Retinal fundus photograph:
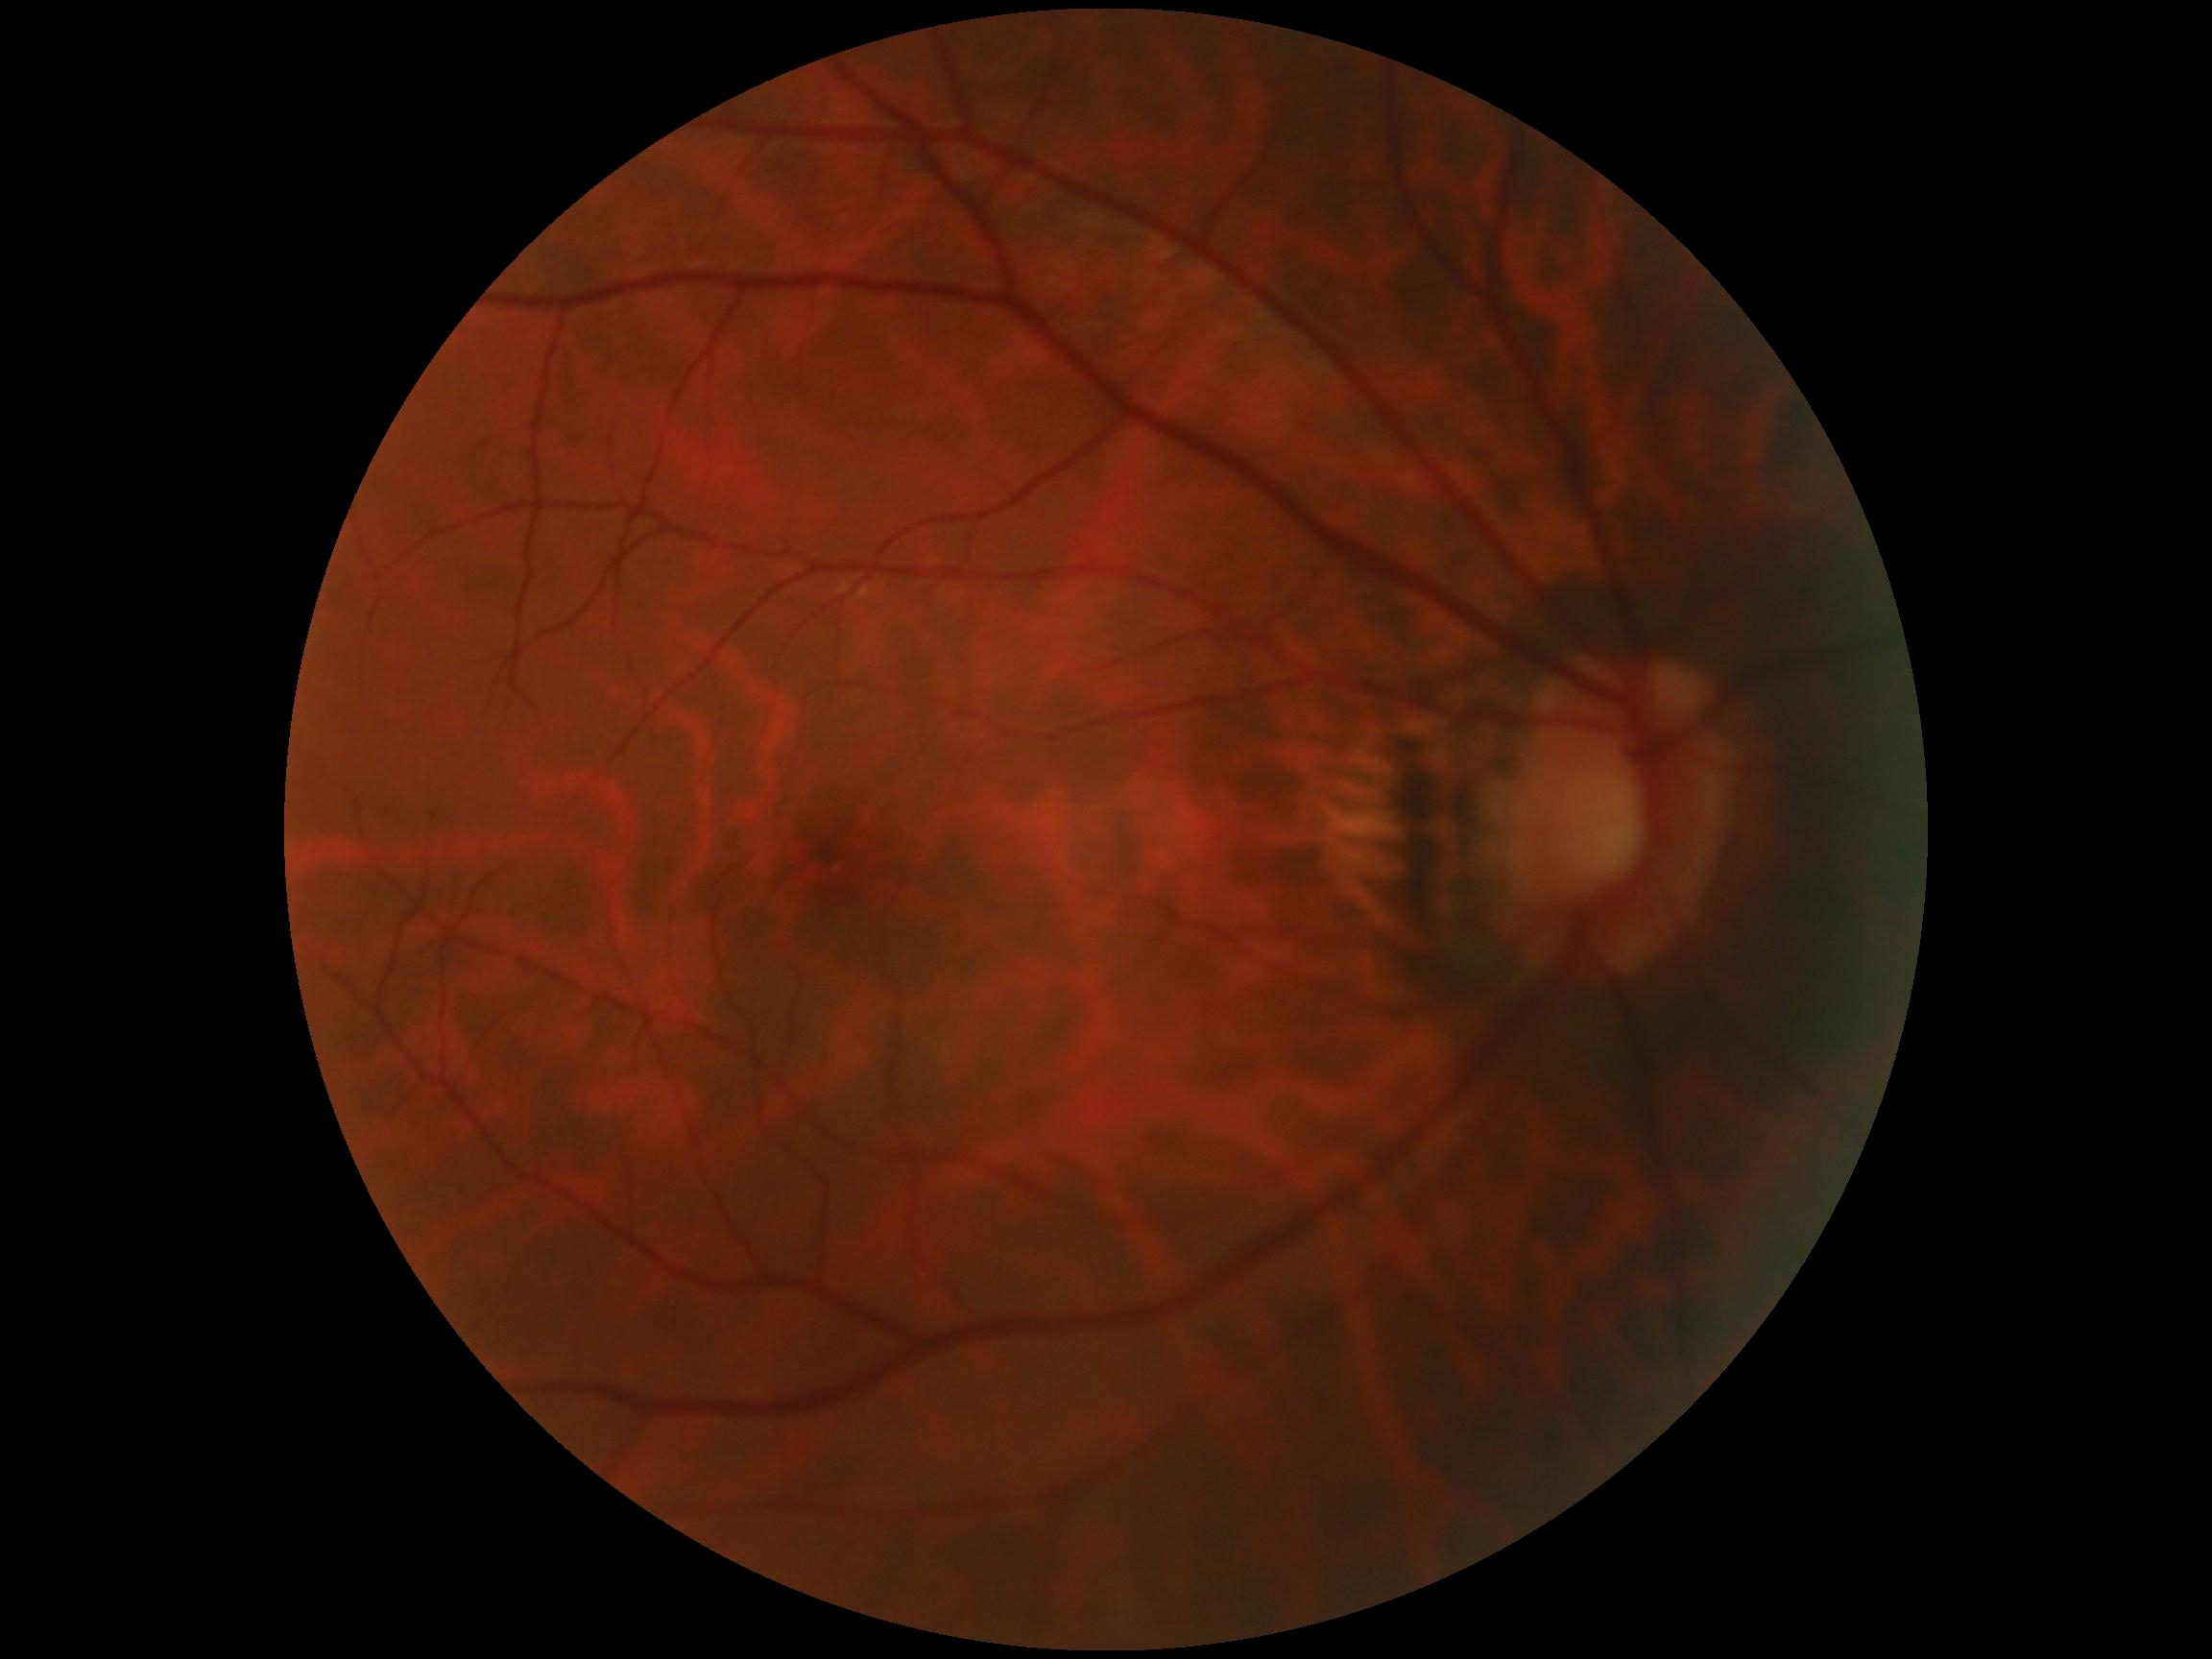
diabetic retinopathy (DR): 0.